45° FOV:
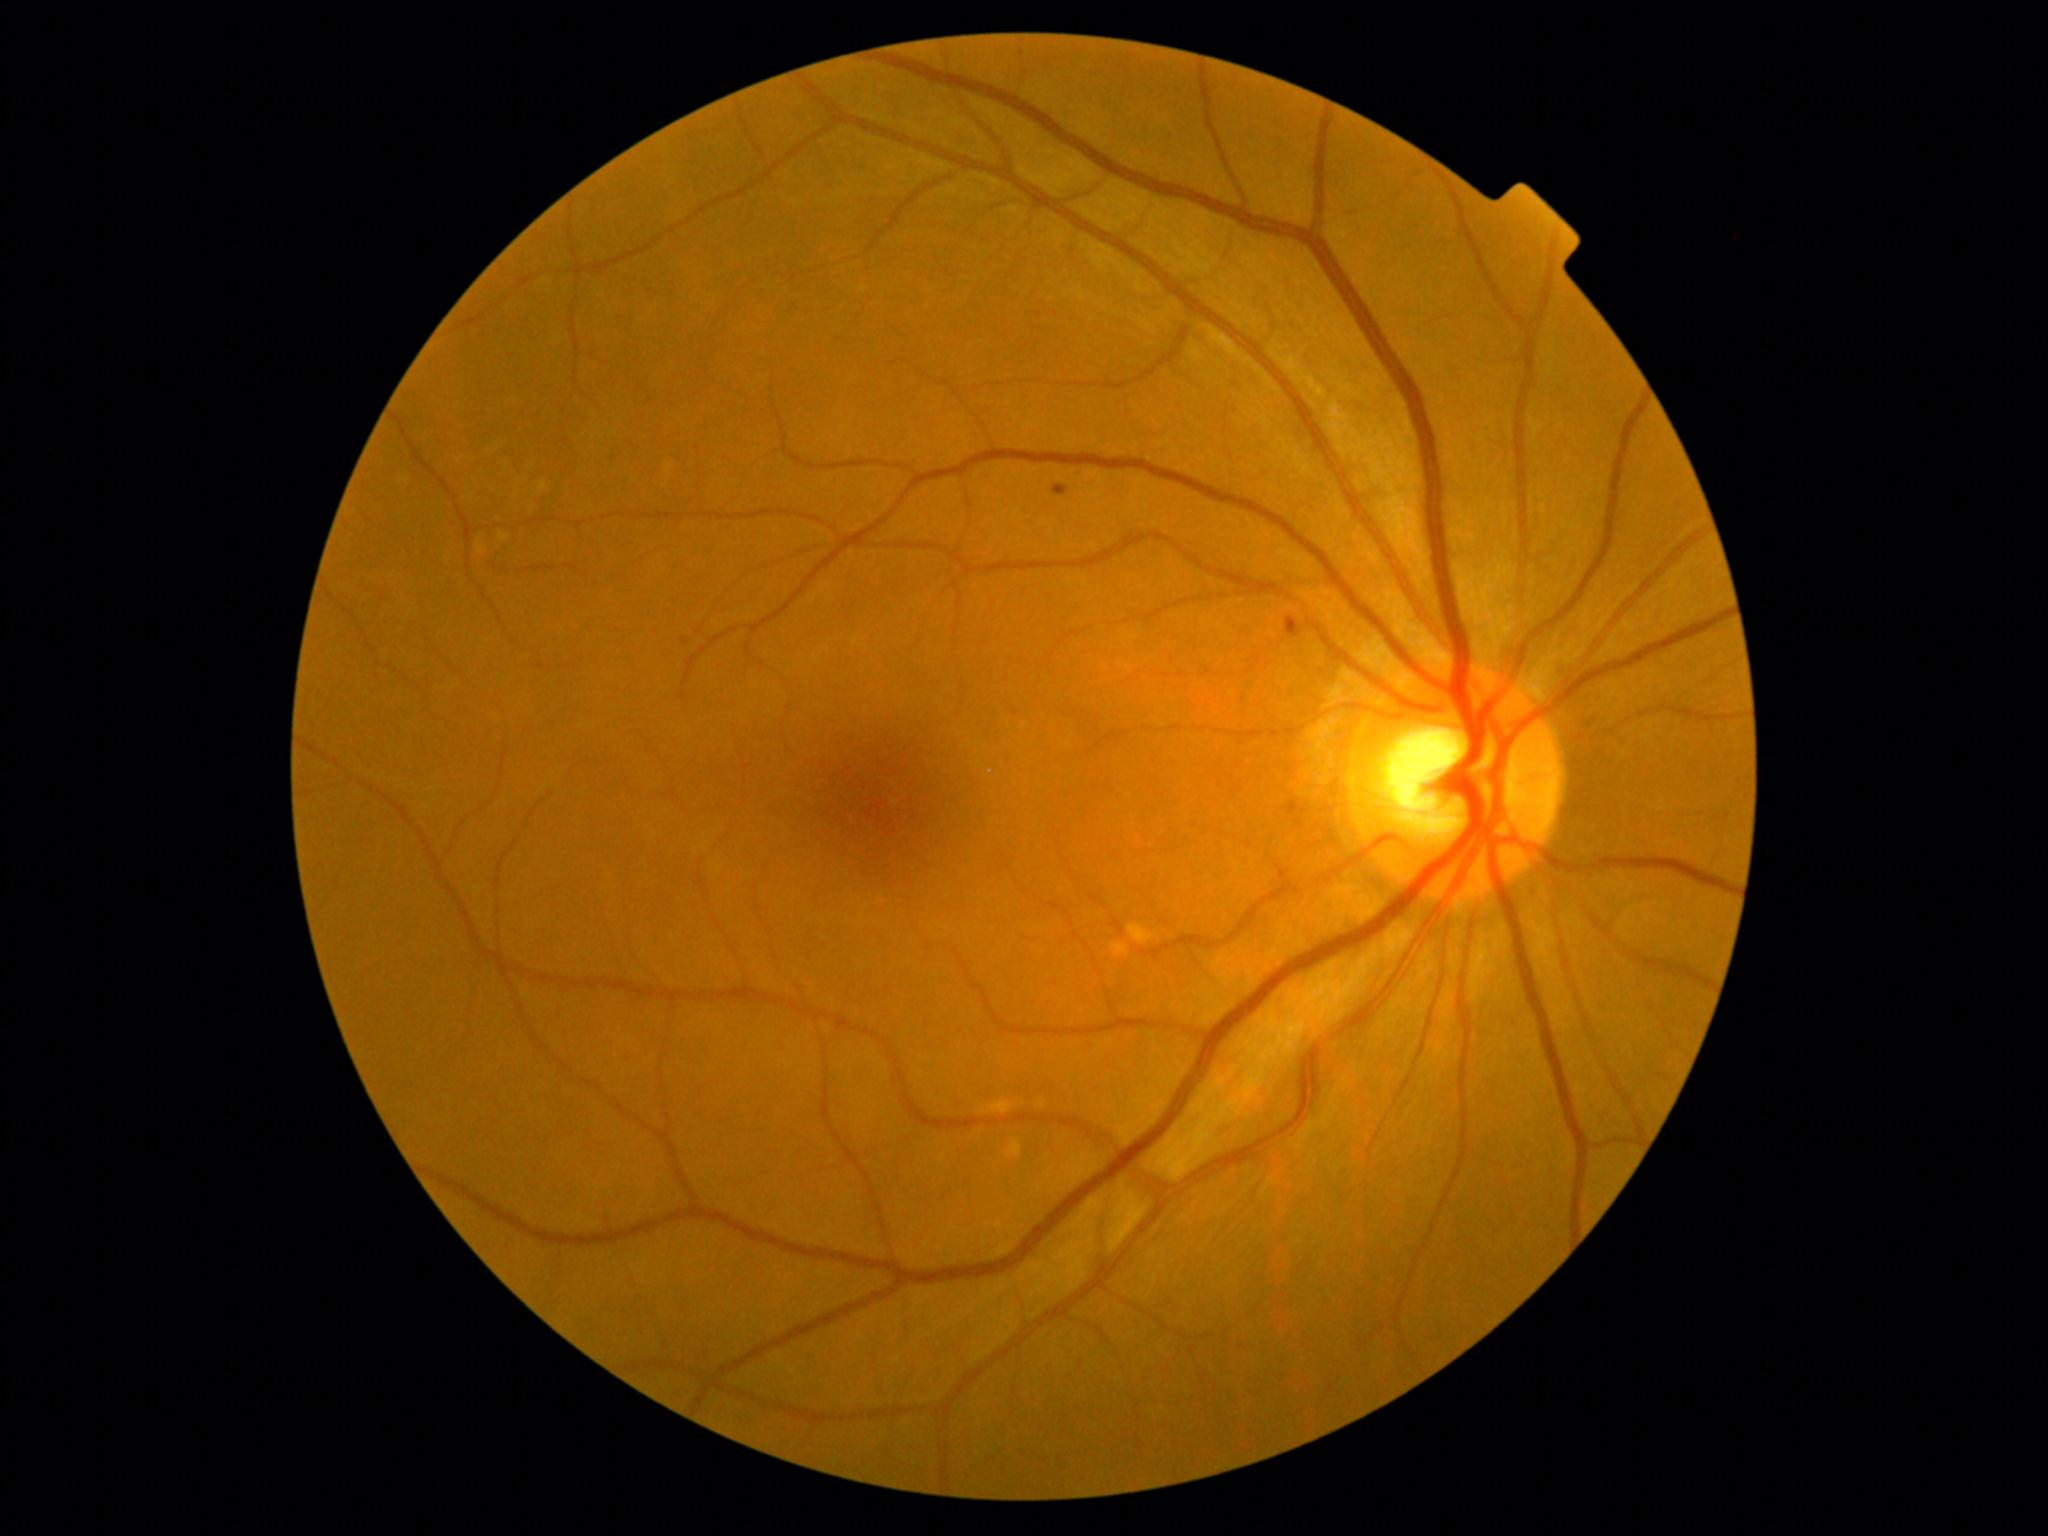
Diabetic retinopathy (DR) is 1/4 — presence of microaneurysms only
A subset of detected lesions:
• microaneurysms (MAs) (subset): (x1=1287, y1=617, x2=1302, y2=637) | (x1=612, y1=458, x2=621, y2=466) | (x1=1053, y1=485, x2=1069, y2=496)
• Small MAs approximately at [686,641]
• soft exudates (SEs): none
• hemorrhages (HEs): none
• hard exudates (EXs): none